Infant wide-field retinal image
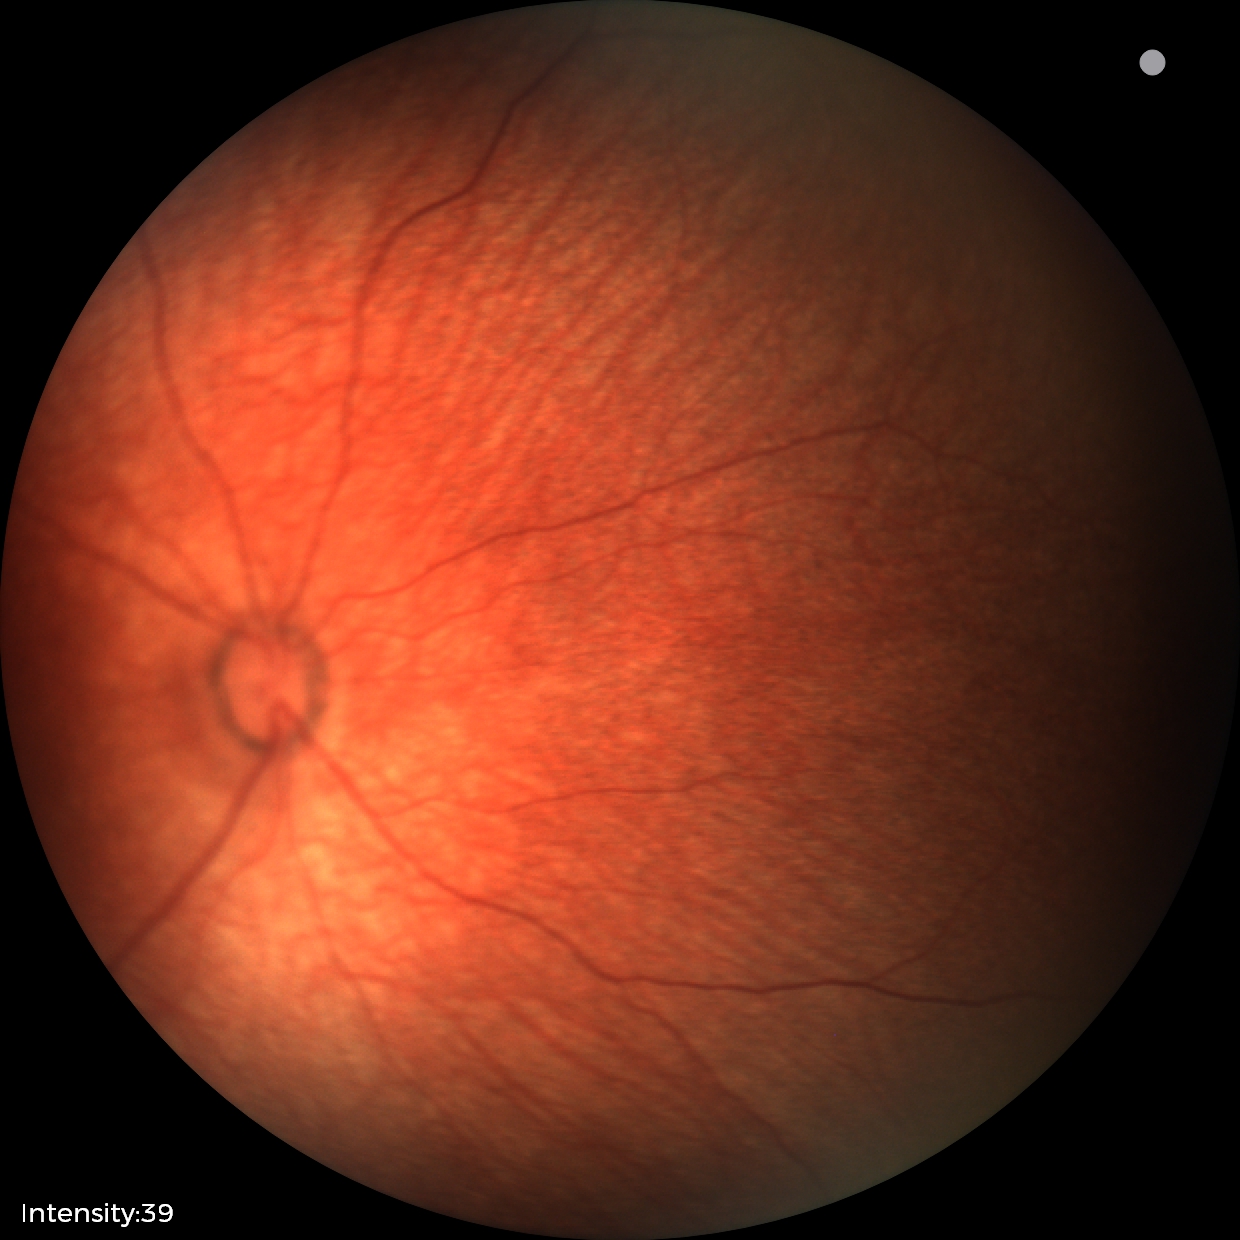 Screening diagnosis: normal fundus examination.